Fundus photo.
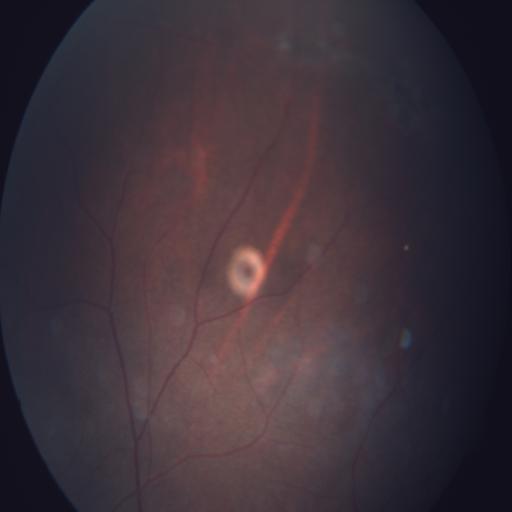 The image shows tessellation (TSLN).